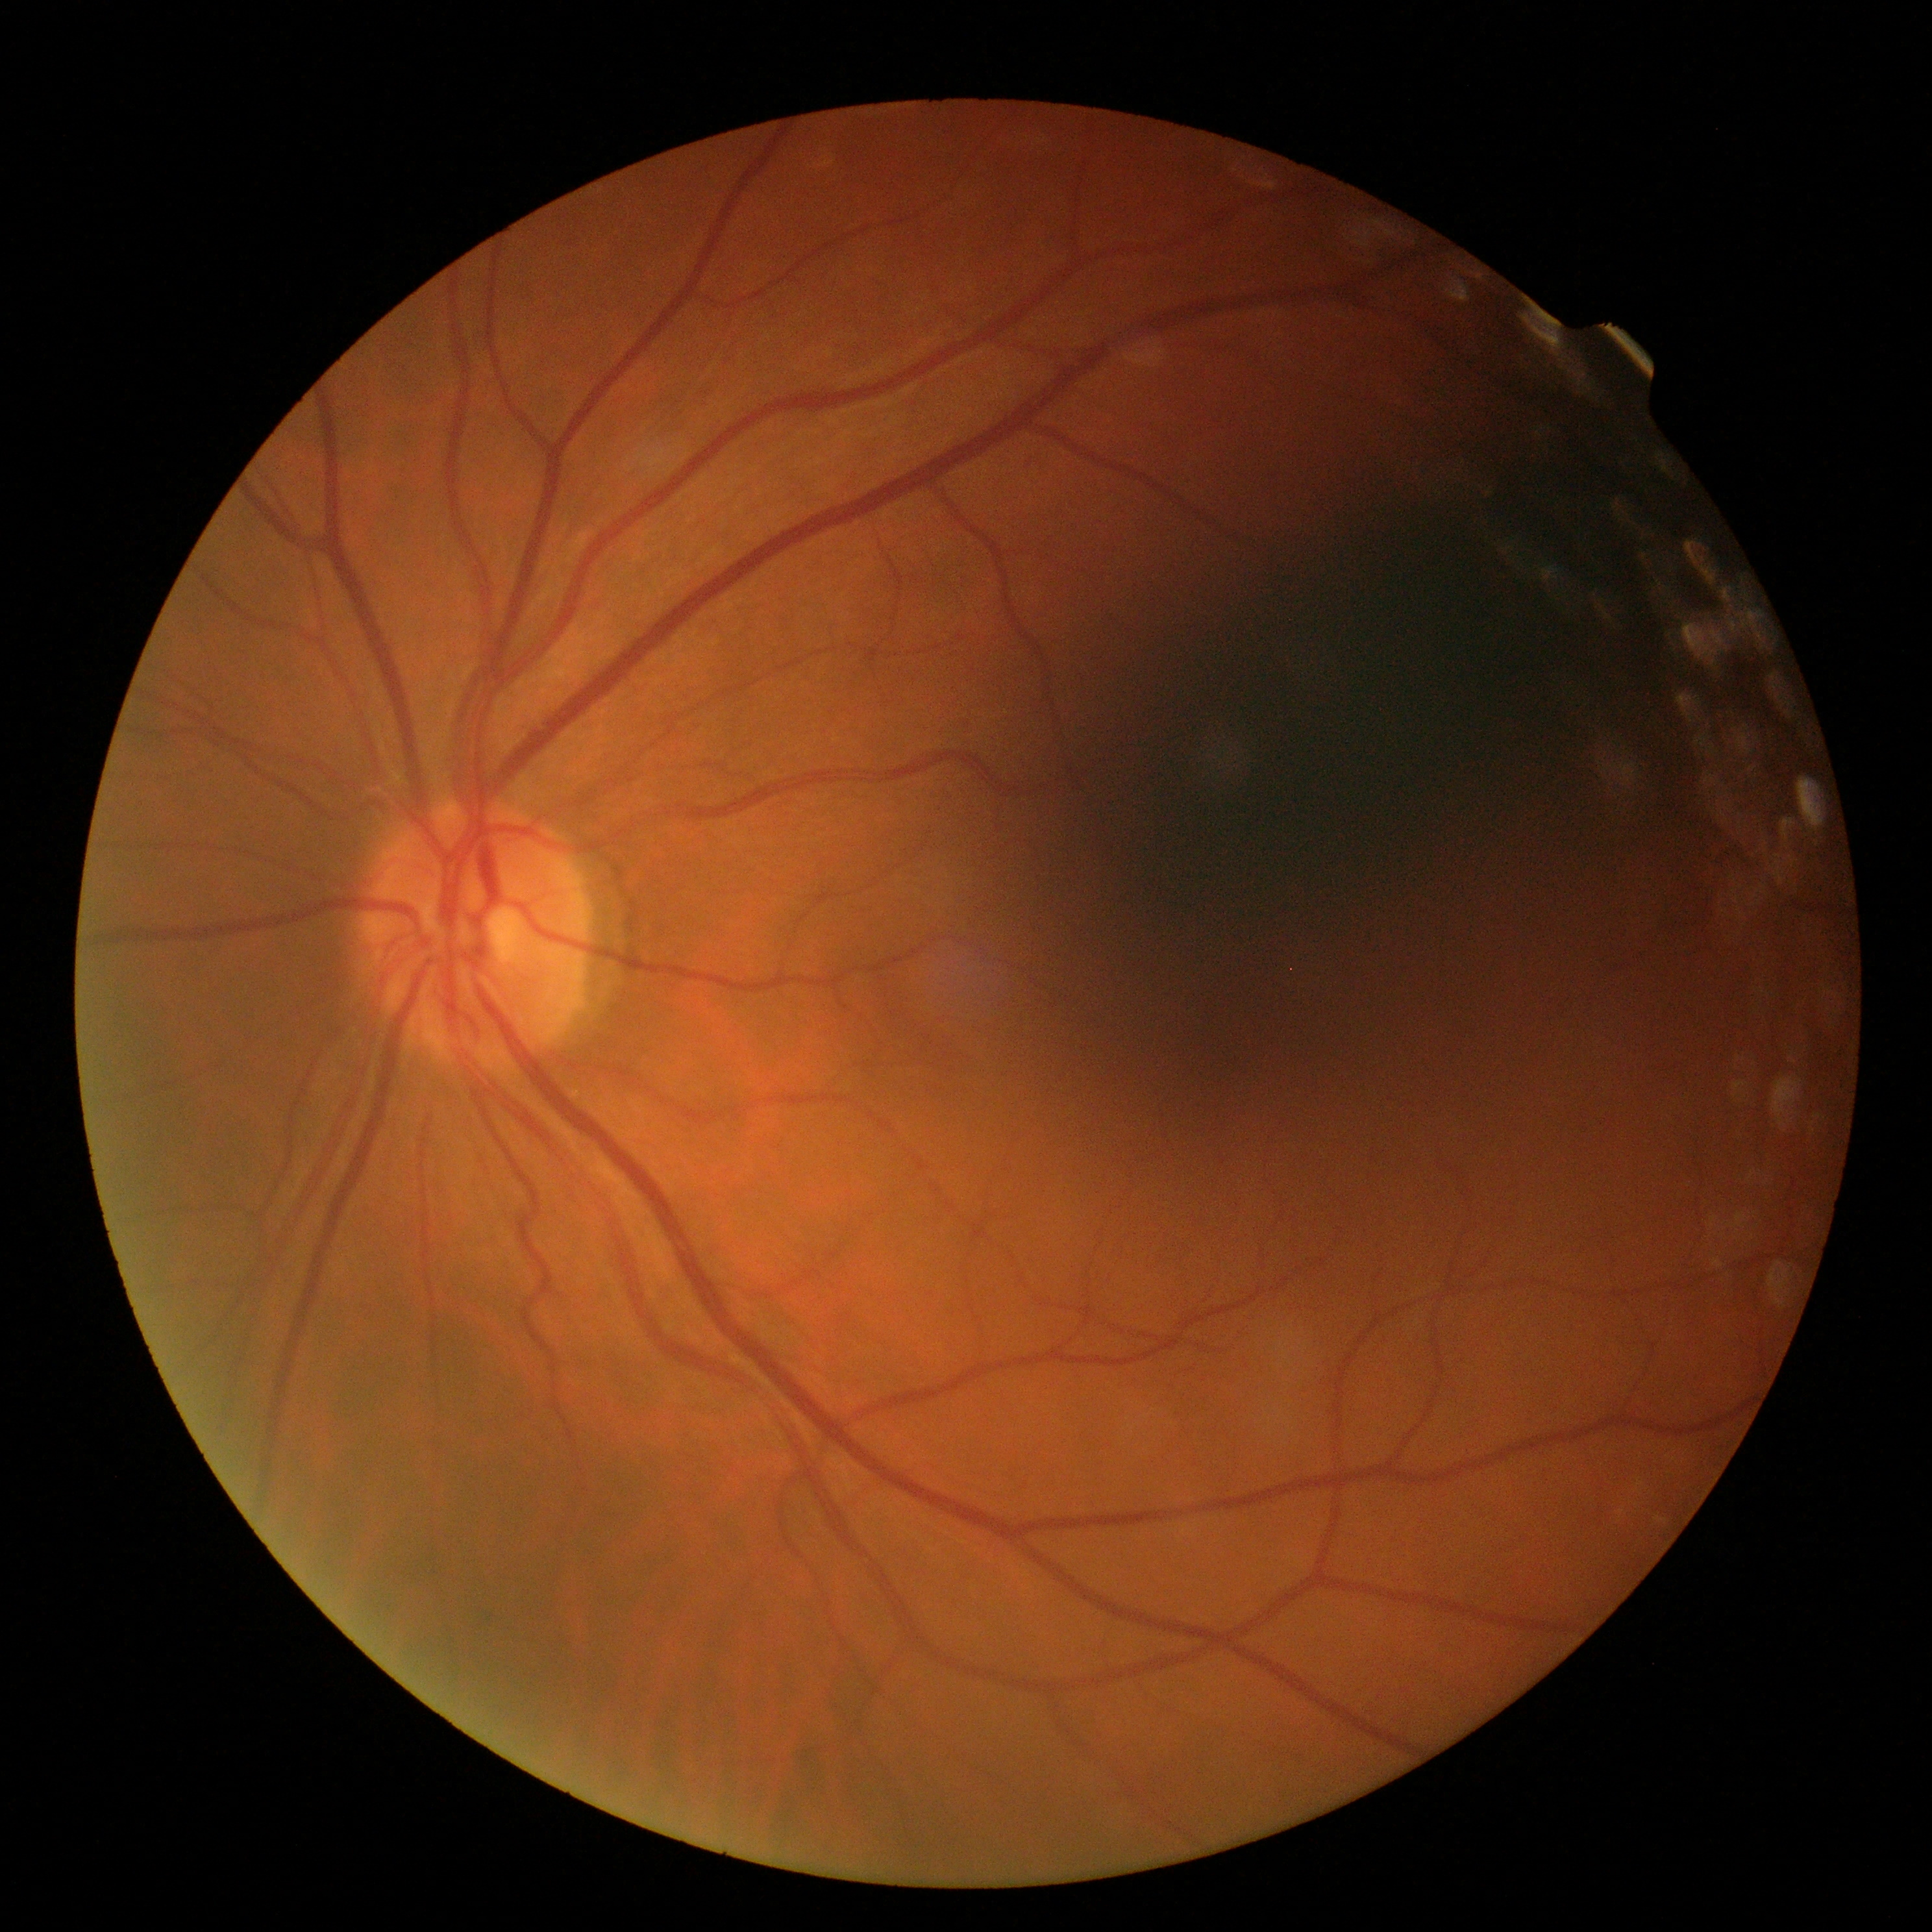
DR stage: grade 0 (no apparent retinopathy).